848 by 848 pixels, modified Davis grading.
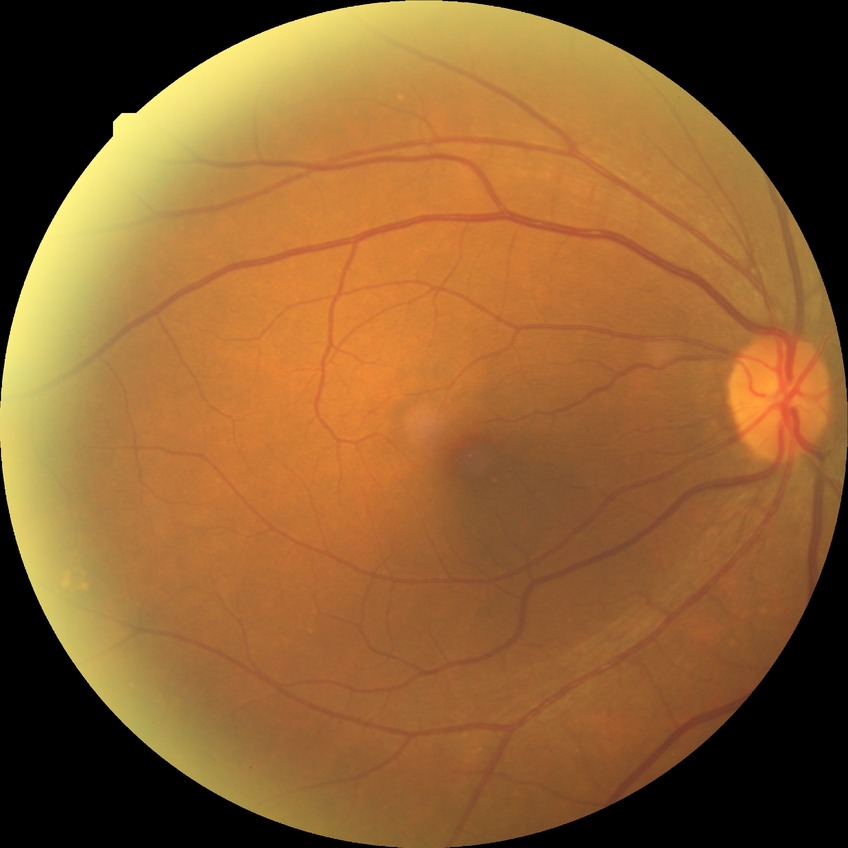
Retinopathy grade: simple diabetic retinopathy.